NIDEK AFC-230.
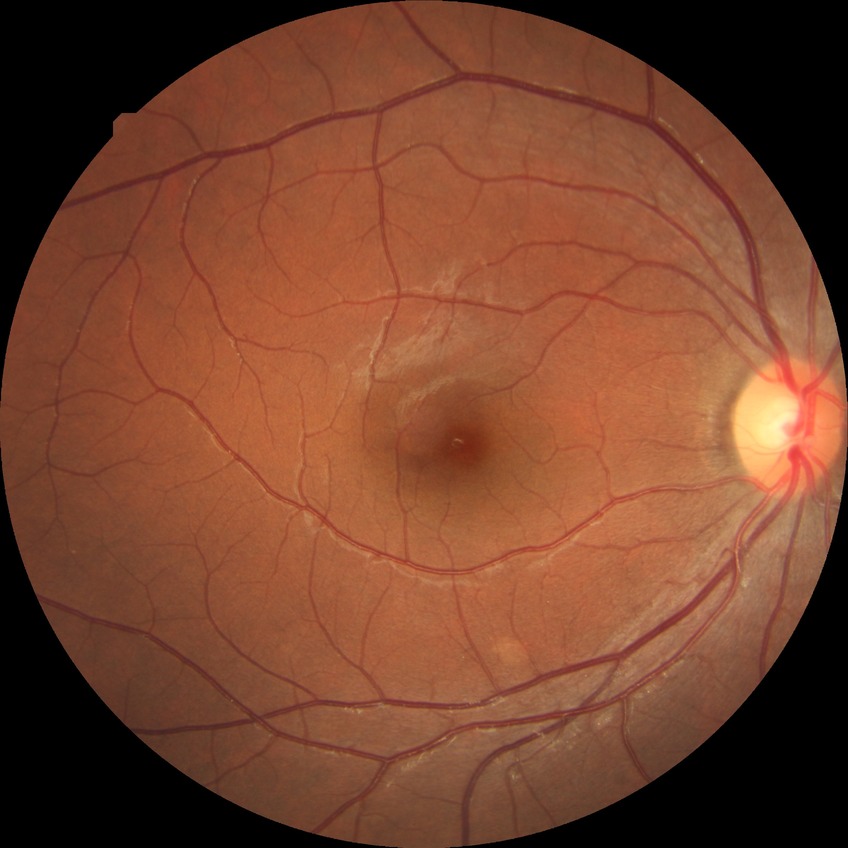

Diabetic retinopathy (DR): NDR (no diabetic retinopathy).